2352 by 1568 pixels: 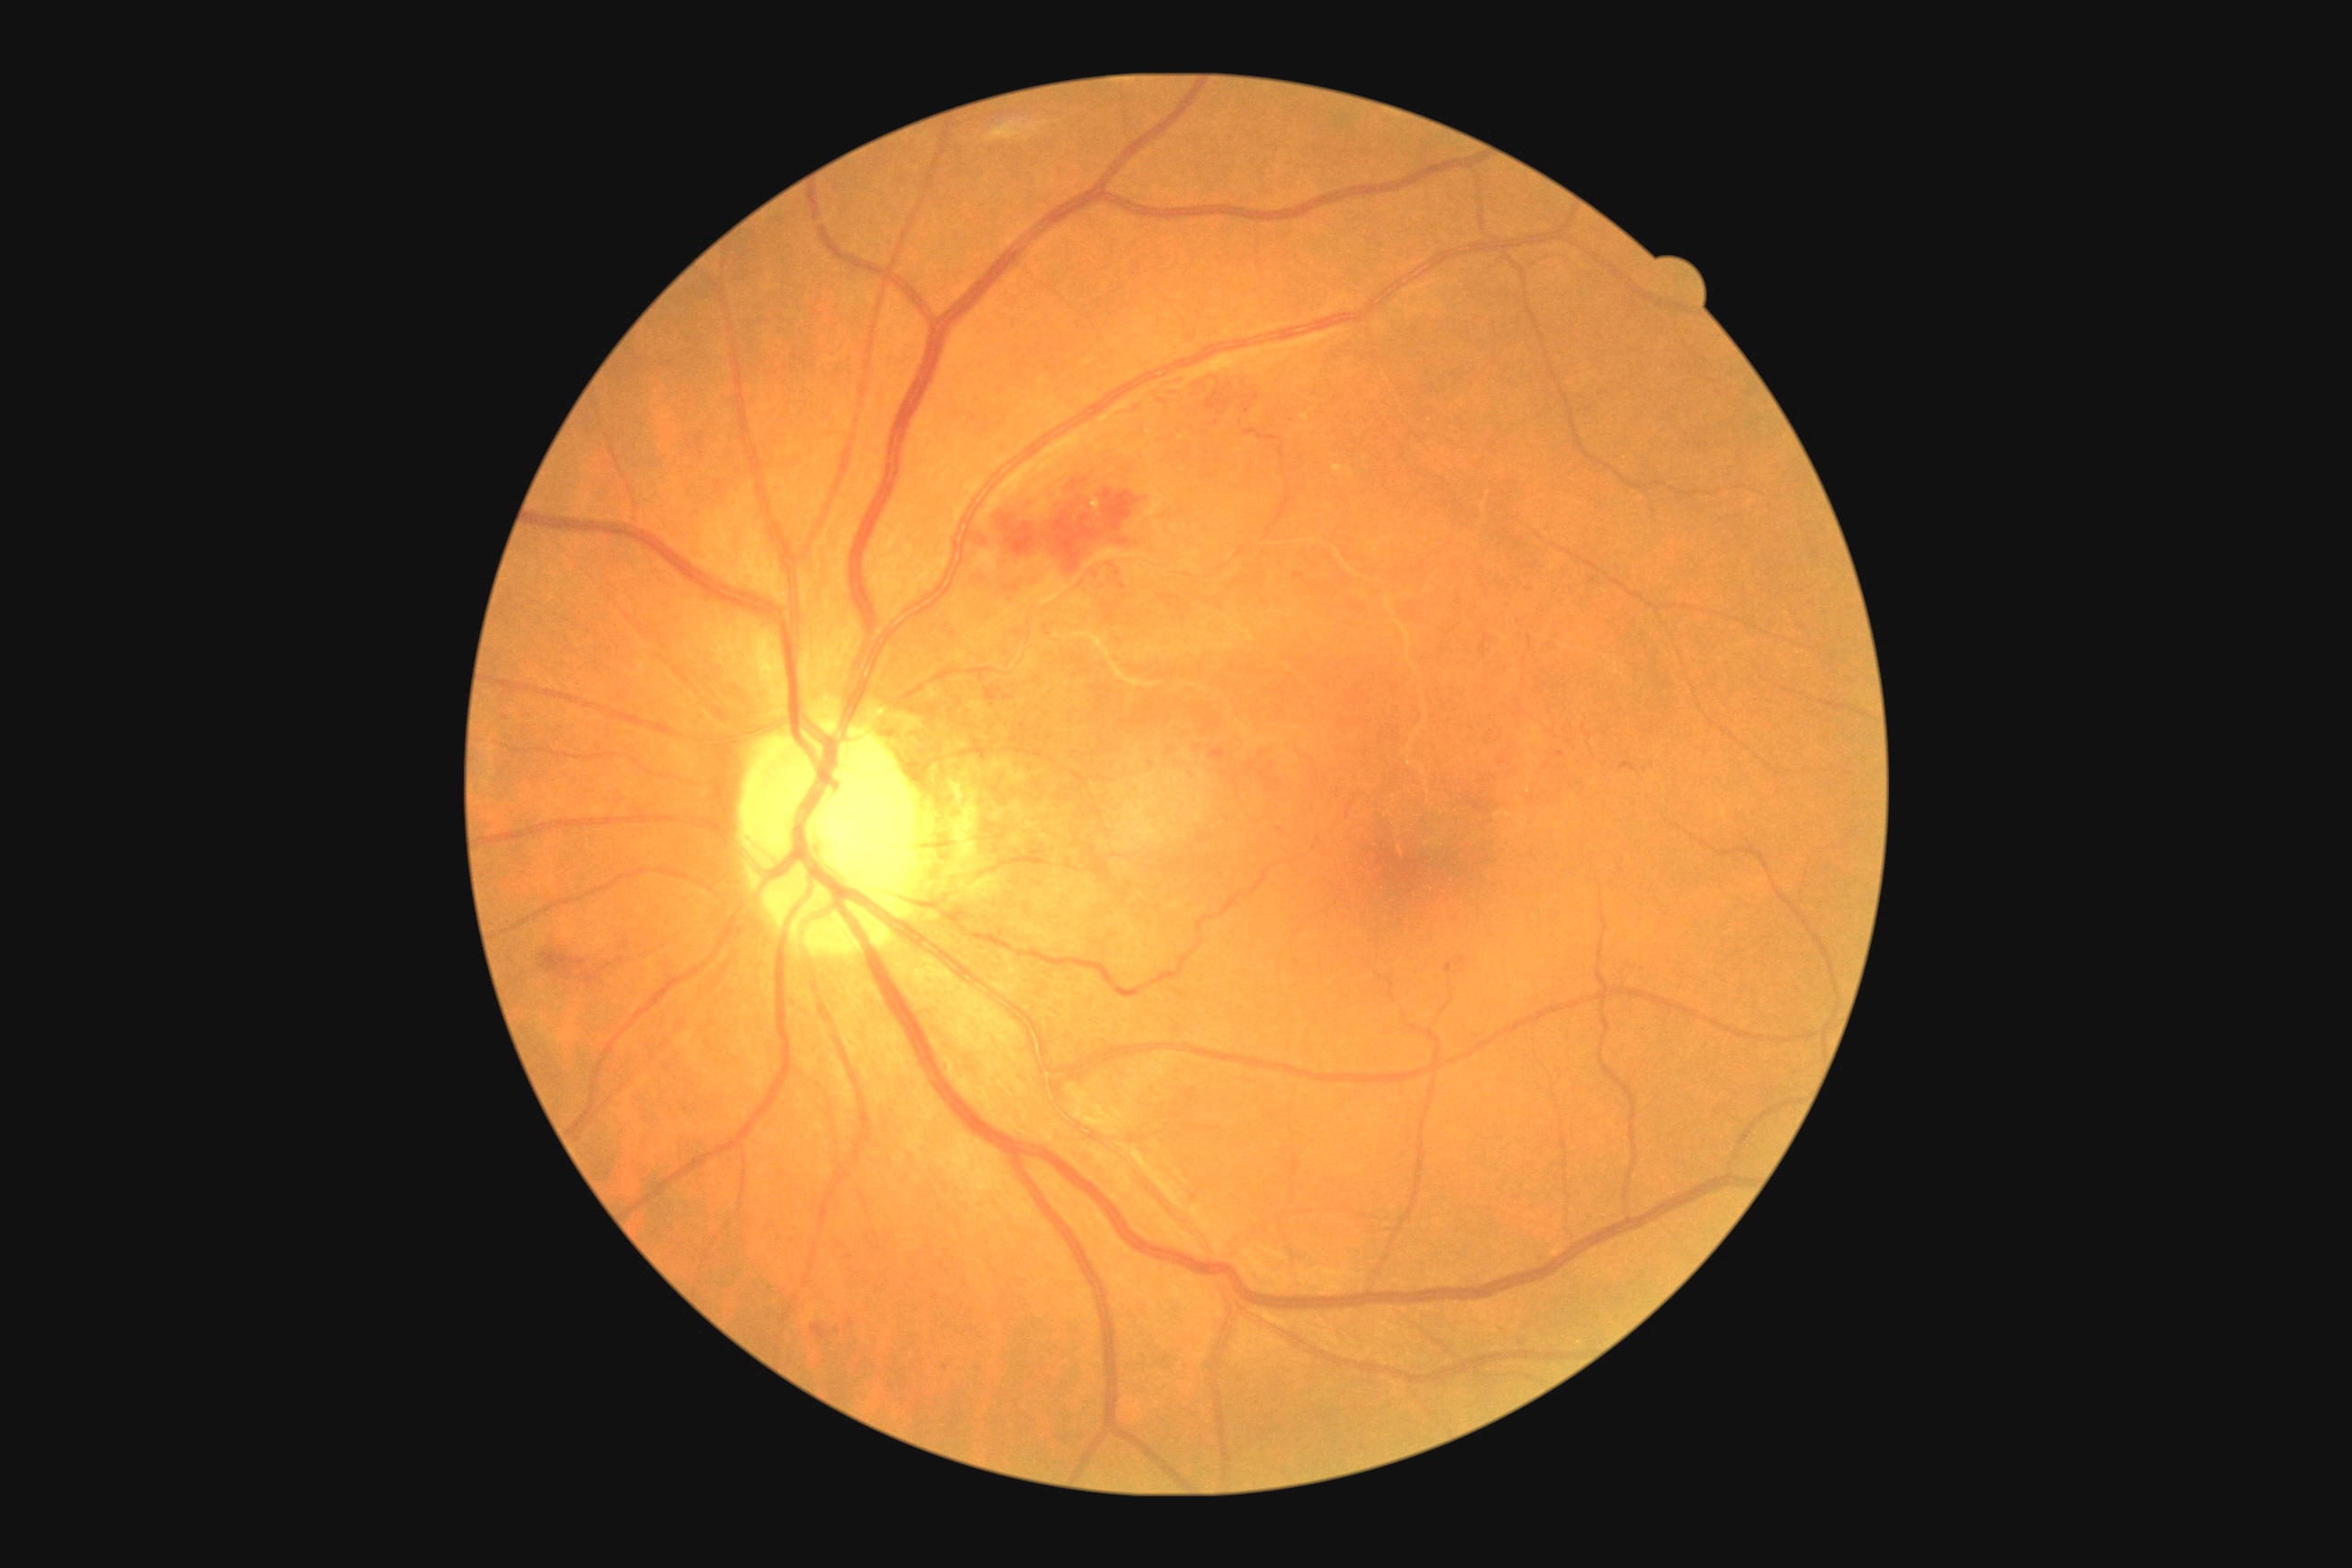 Retinopathy grade is 3 (severe NPDR) — more than 20 intraretinal hemorrhages in each of 4 quadrants, definite venous beading in 2 or more quadrants, or prominent intraretinal microvascular abnormalities in 1 or more quadrants, with no signs of proliferative retinopathy
A subset of detected lesions:
hemorrhages (partial) = (left=812, top=1324, right=830, bottom=1338) | (left=1622, top=763, right=1636, bottom=772) | (left=1589, top=574, right=1602, bottom=582) | (left=1213, top=369, right=1262, bottom=411) | (left=538, top=934, right=663, bottom=985) | (left=959, top=462, right=1175, bottom=609) | (left=1211, top=749, right=1226, bottom=760) | (left=1522, top=582, right=1534, bottom=594) | (left=1540, top=525, right=1553, bottom=536) | (left=1446, top=956, right=1467, bottom=974)
Hemorrhages (small, approximate centers) near Point(945, 1368) | Point(1296, 577) | Point(851, 1323) | Point(1561, 754) | Point(837, 1331)
soft exudates = absent
hard exudates = (left=1088, top=493, right=1102, bottom=516) | (left=1333, top=466, right=1353, bottom=478)
Hard exudates (small, approximate centers) near Point(1181, 439) | Point(1150, 433)
microaneurysms = absent